Wide-field fundus photograph from neonatal ROP screening
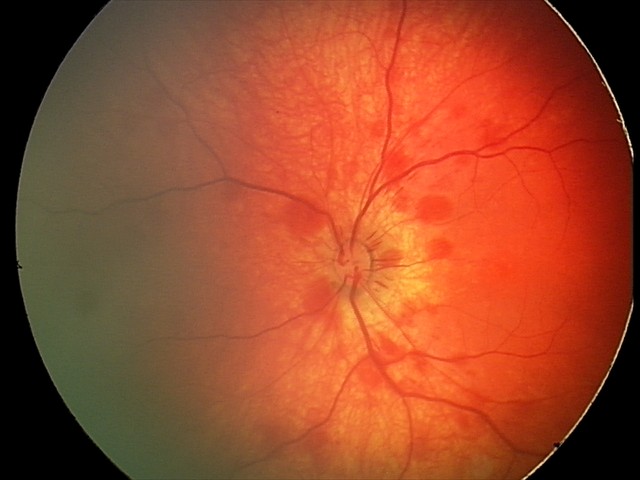

Diagnosis from this screening exam: retinal hemorrhages.